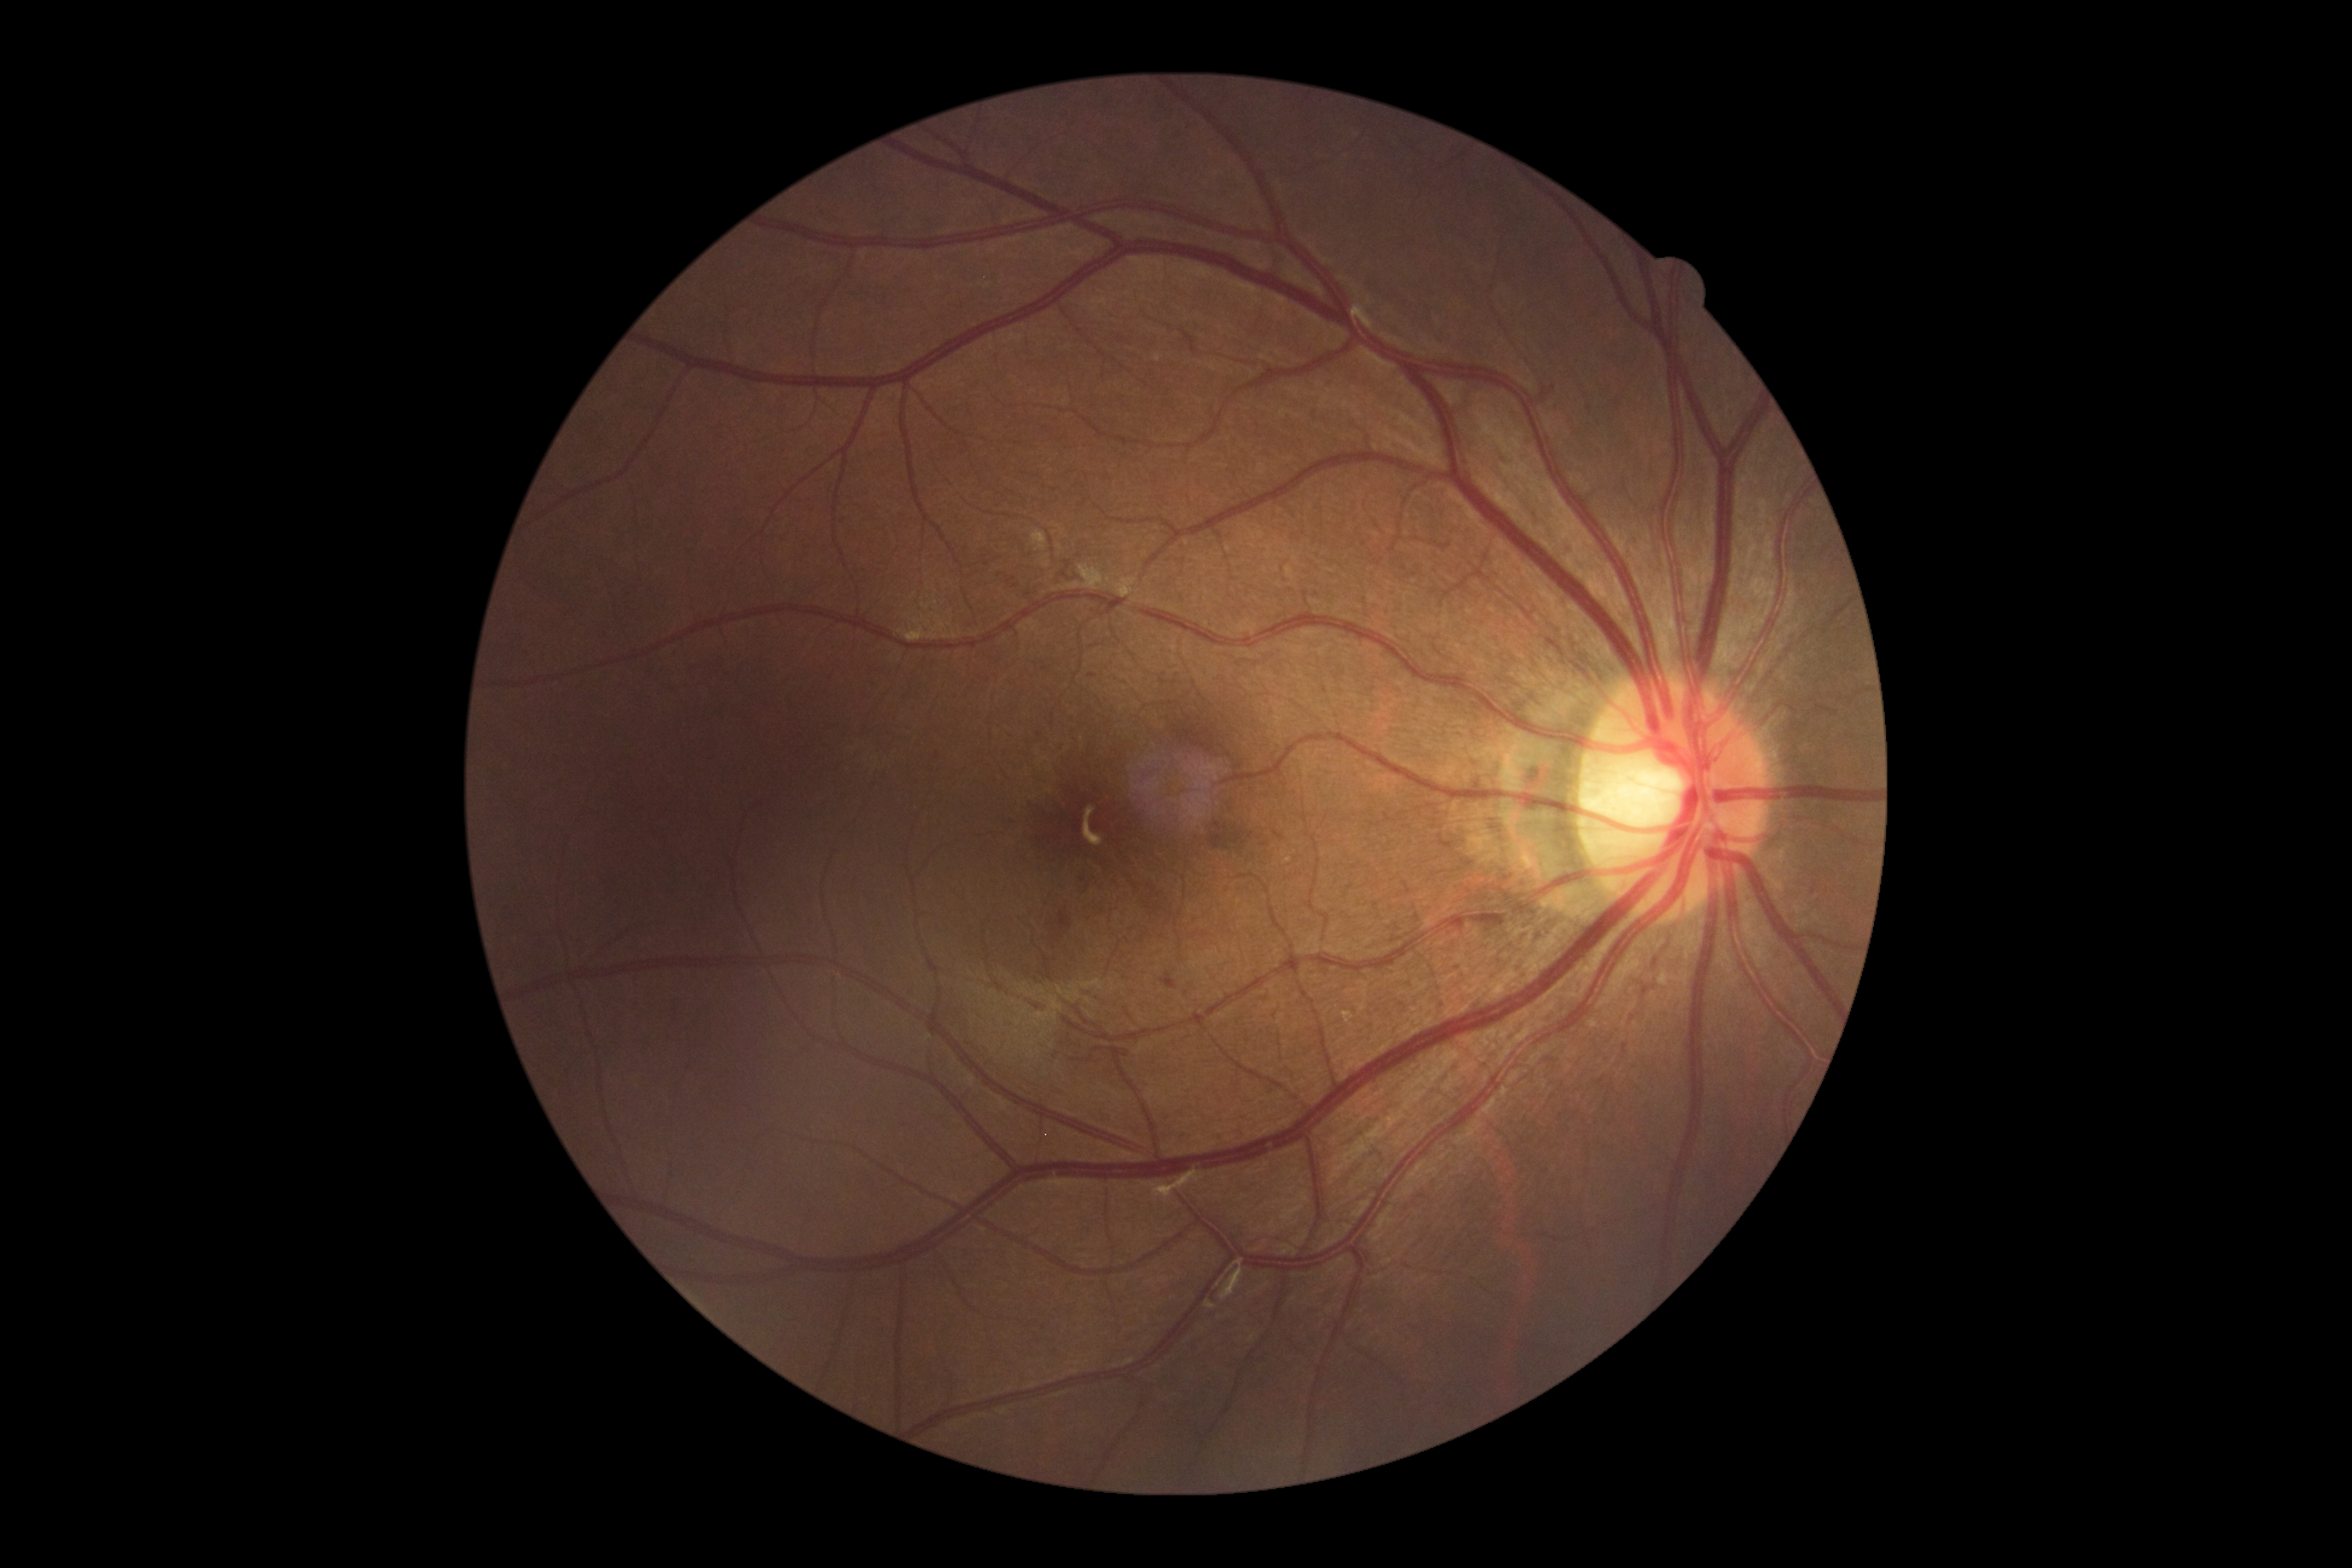
Findings:
– DR stage — moderate NPDR (grade 2)